2352 x 1568 pixels · 45° FOV · CFP.
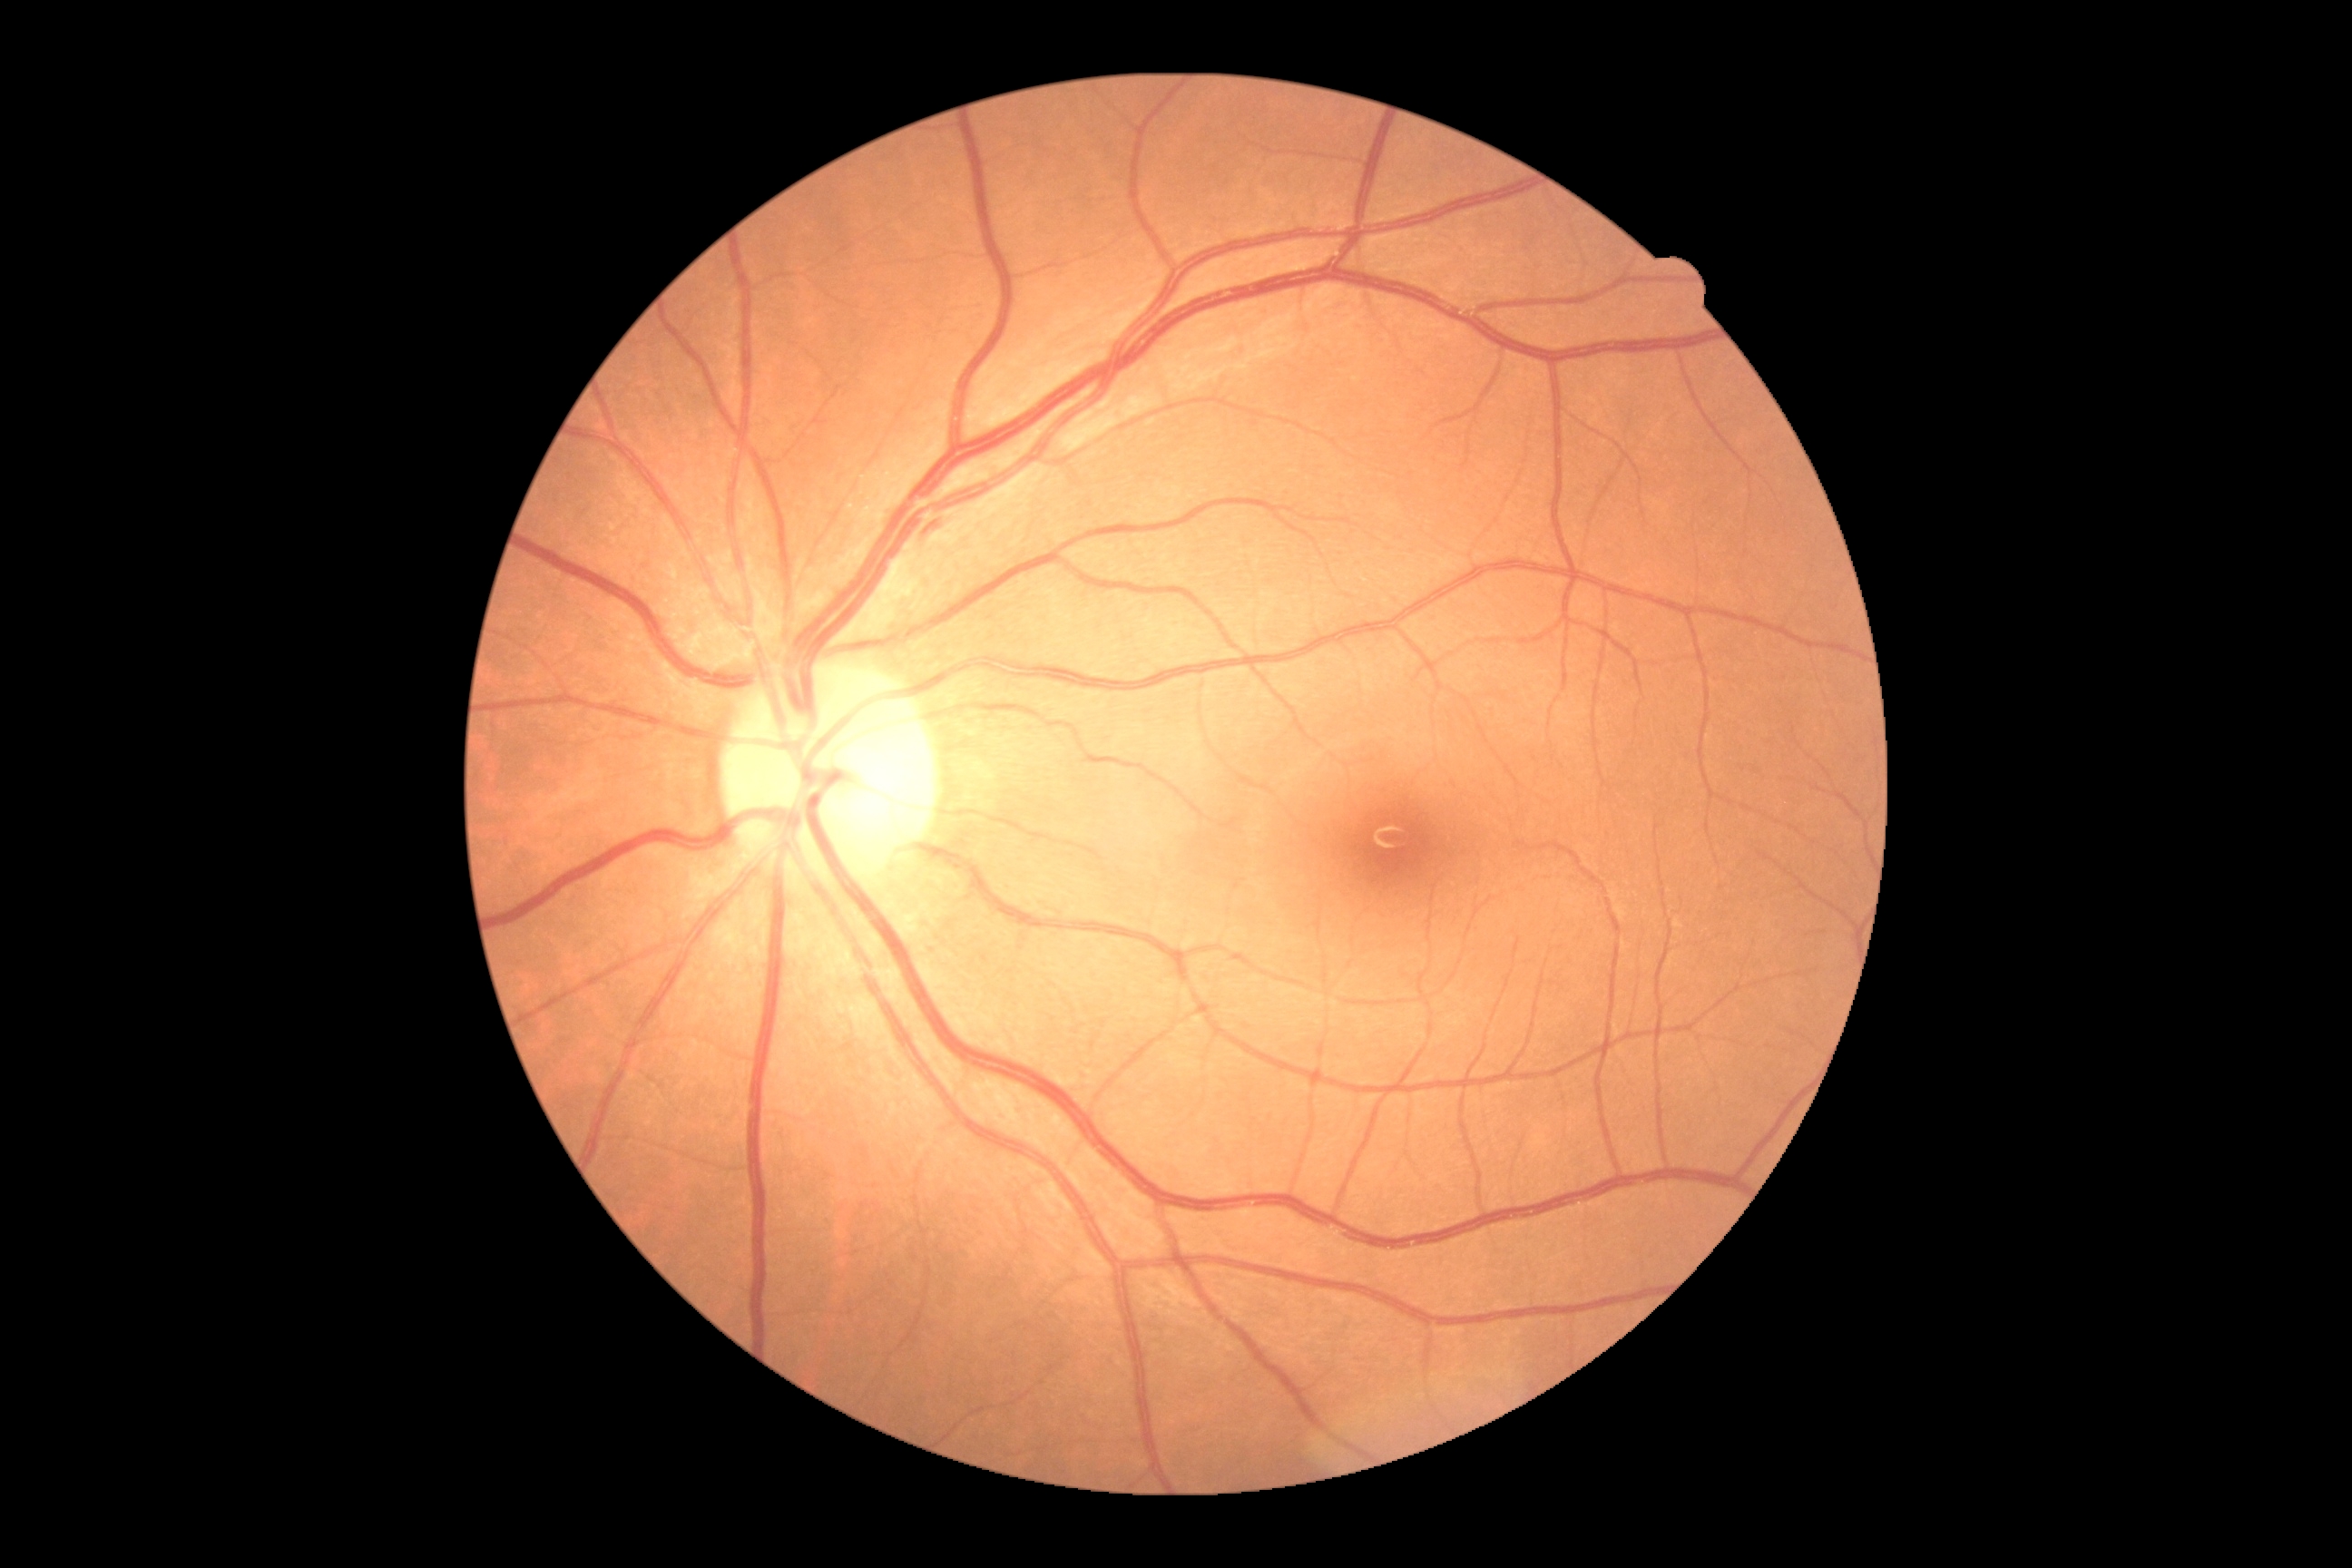 Retinopathy grade is 0 (no apparent retinopathy) — no visible signs of diabetic retinopathy. No signs of diabetic retinopathy.